Modified Davis grading
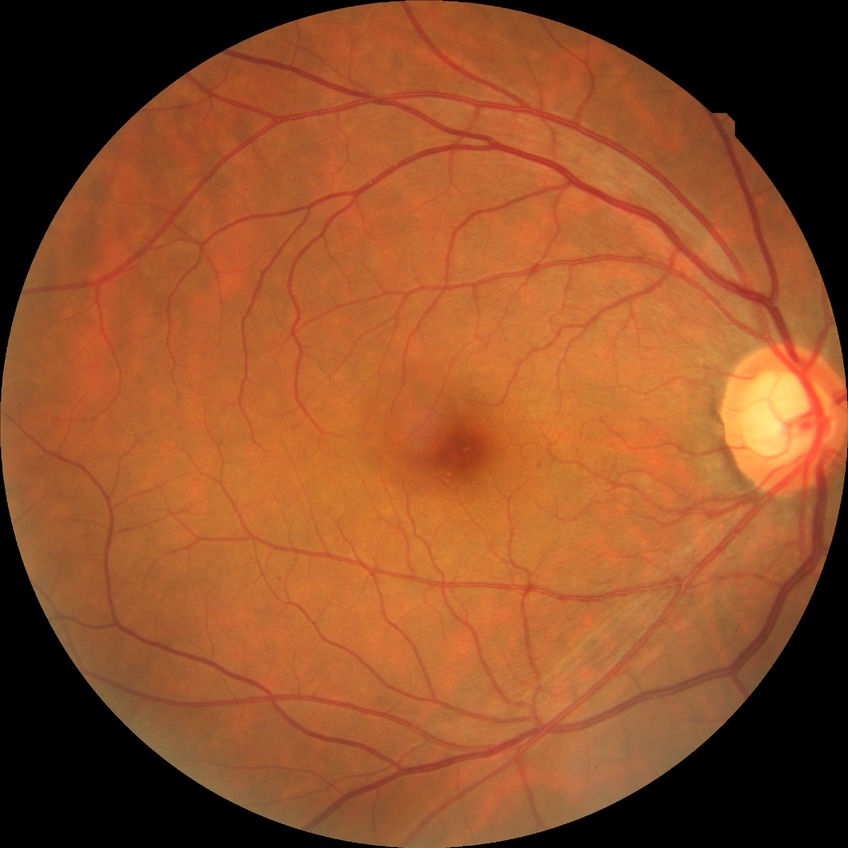 Modified Davis grade: SDR.